UWF retinal mosaic — 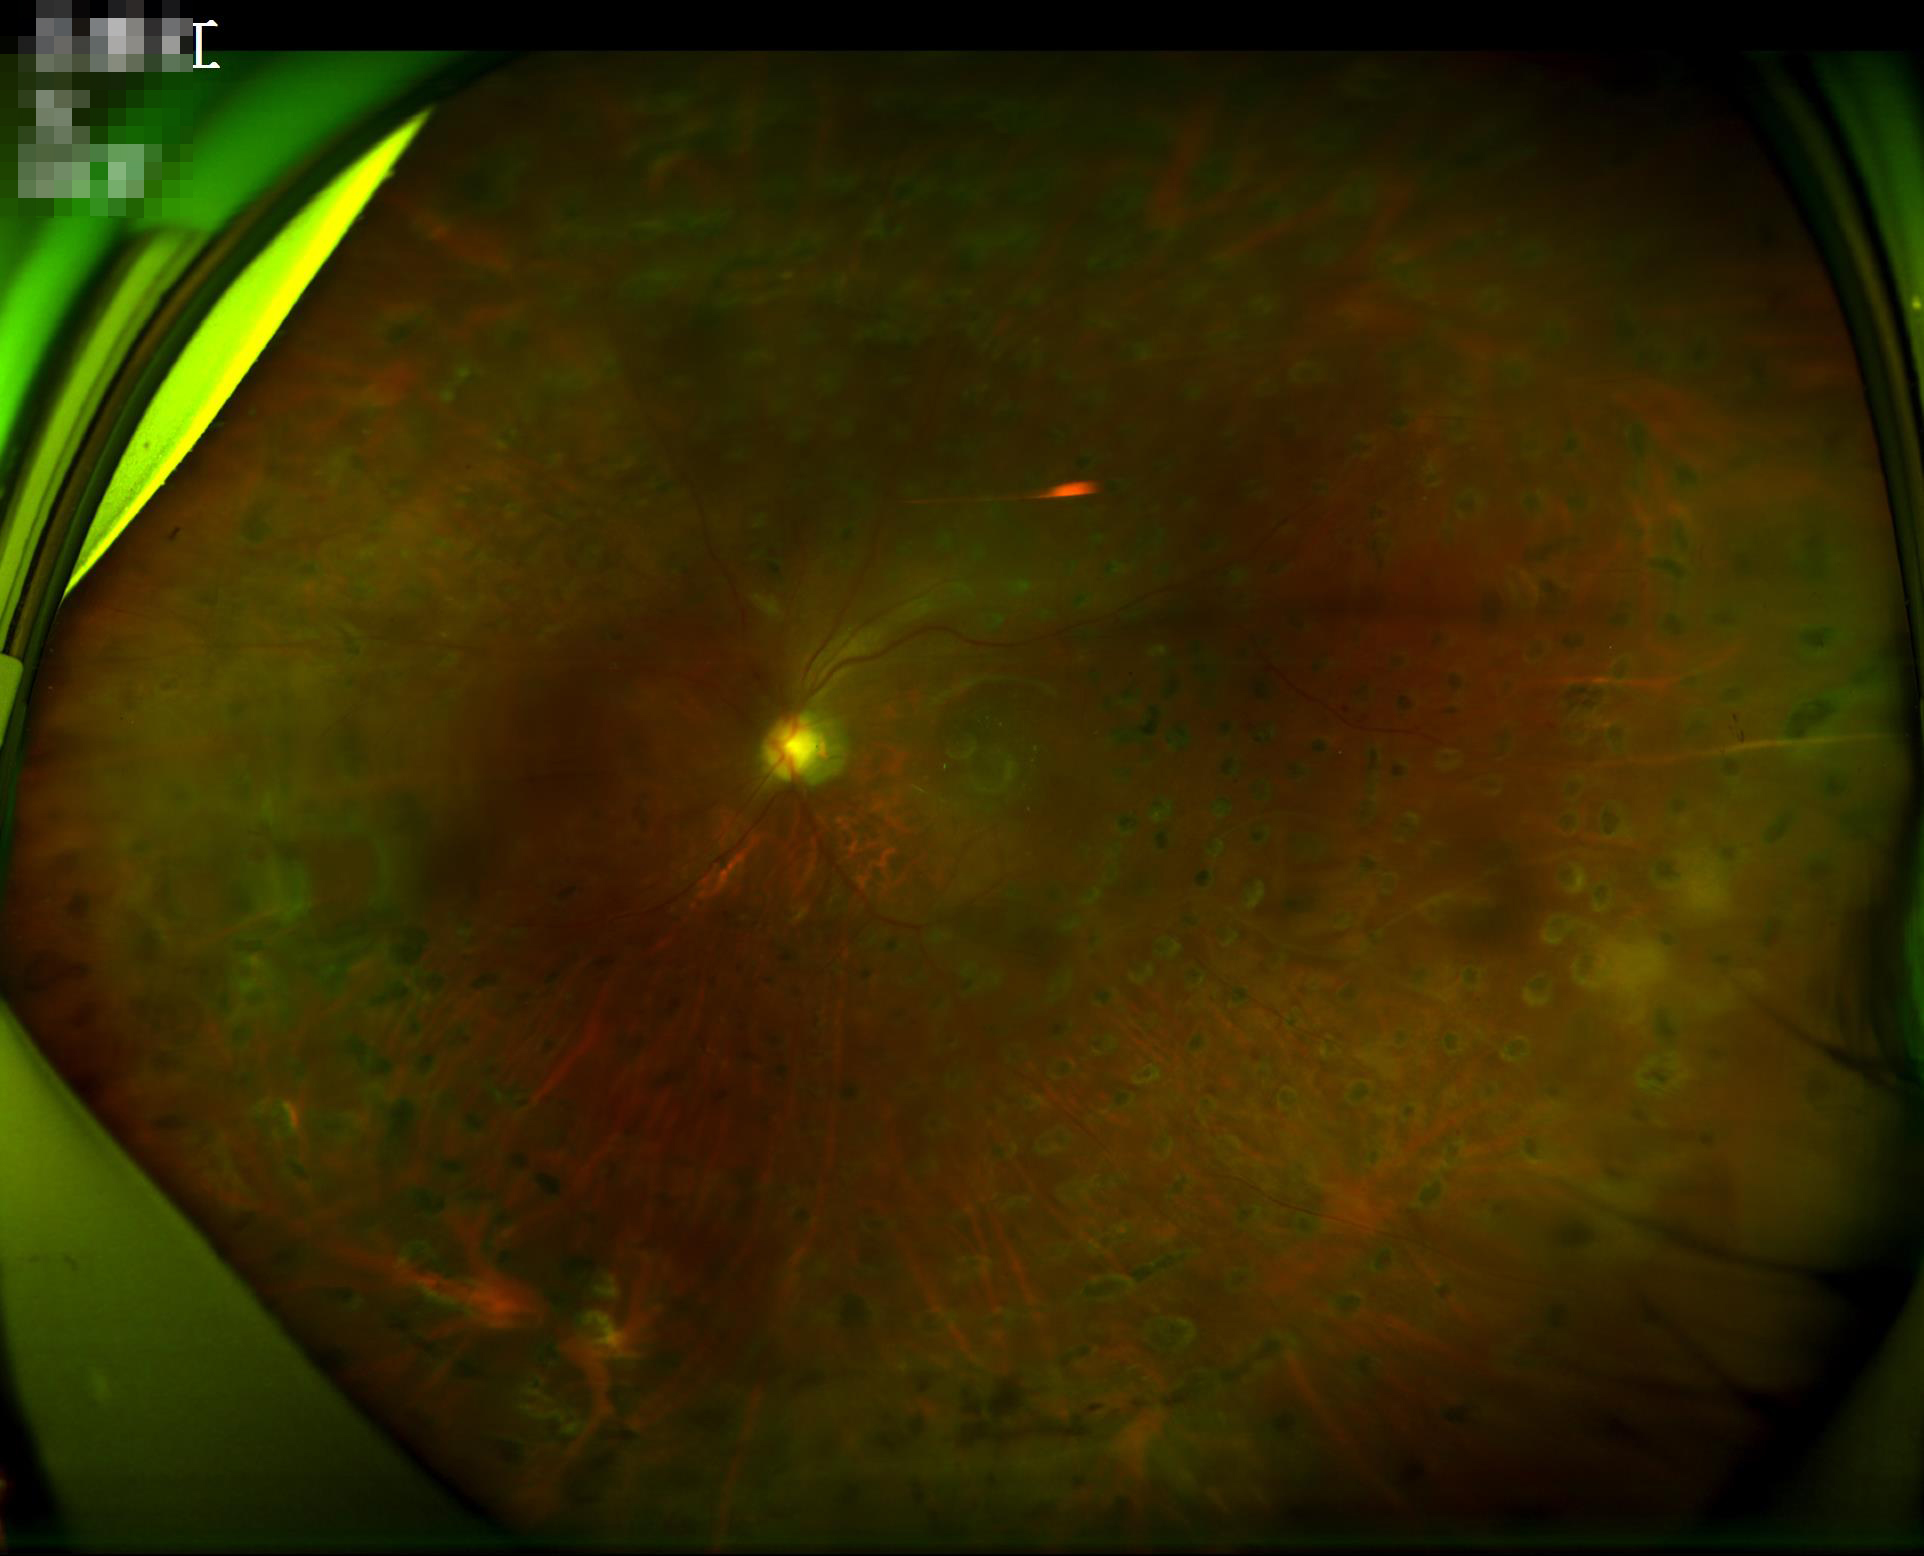
Image quality assessment: contrast: reduced; sharpness: good; illumination: suboptimal; overall: suboptimal.